Image size 240x240
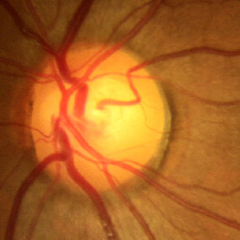 There is evidence of no glaucomatous findings.